45-degree field of view: 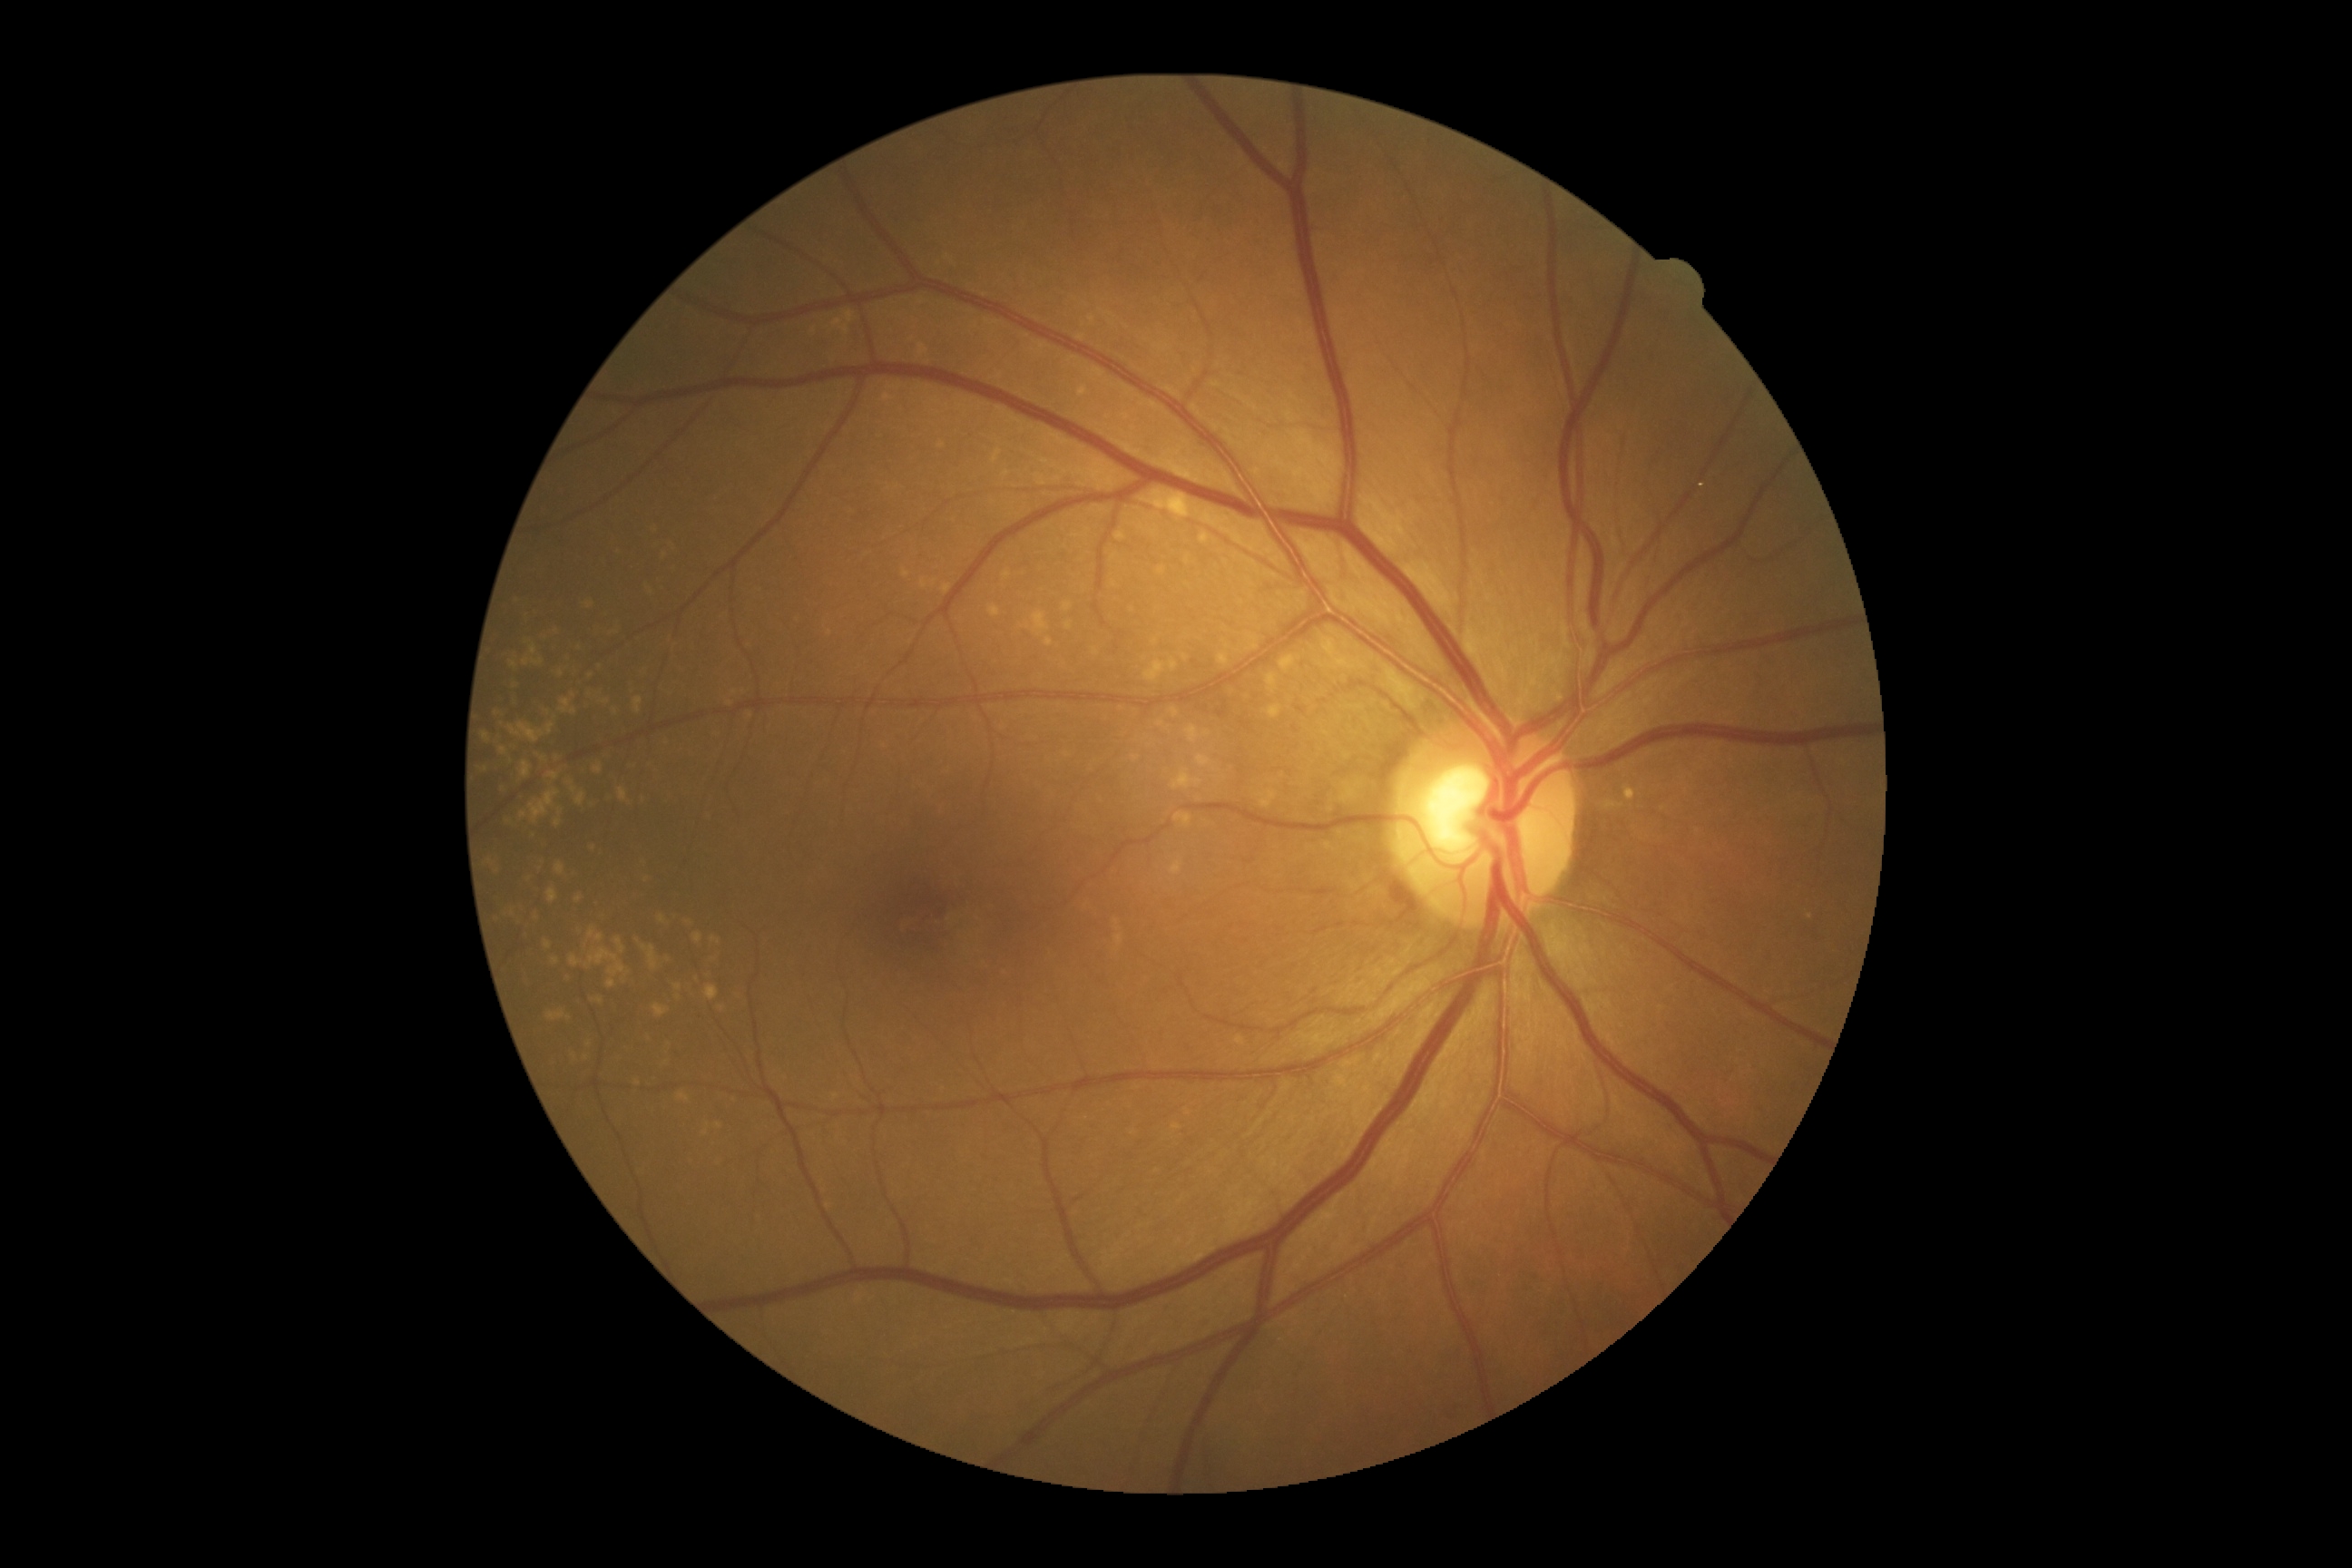

Diabetic retinopathy (DR): 0/4 — no visible signs of diabetic retinopathy.